Modified Davis classification. Image size 848x848. Posterior pole color fundus photograph. 45° FOV. Nonmydriatic
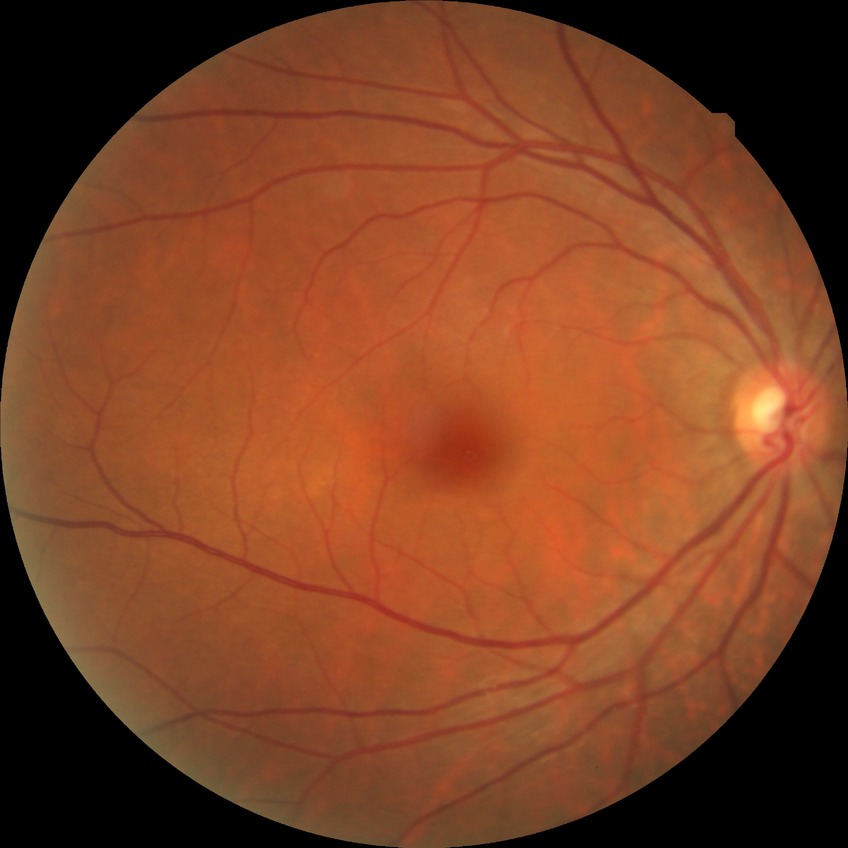

  davis_grade: no diabetic retinopathy